45-degree field of view. NIDEK AFC-230.
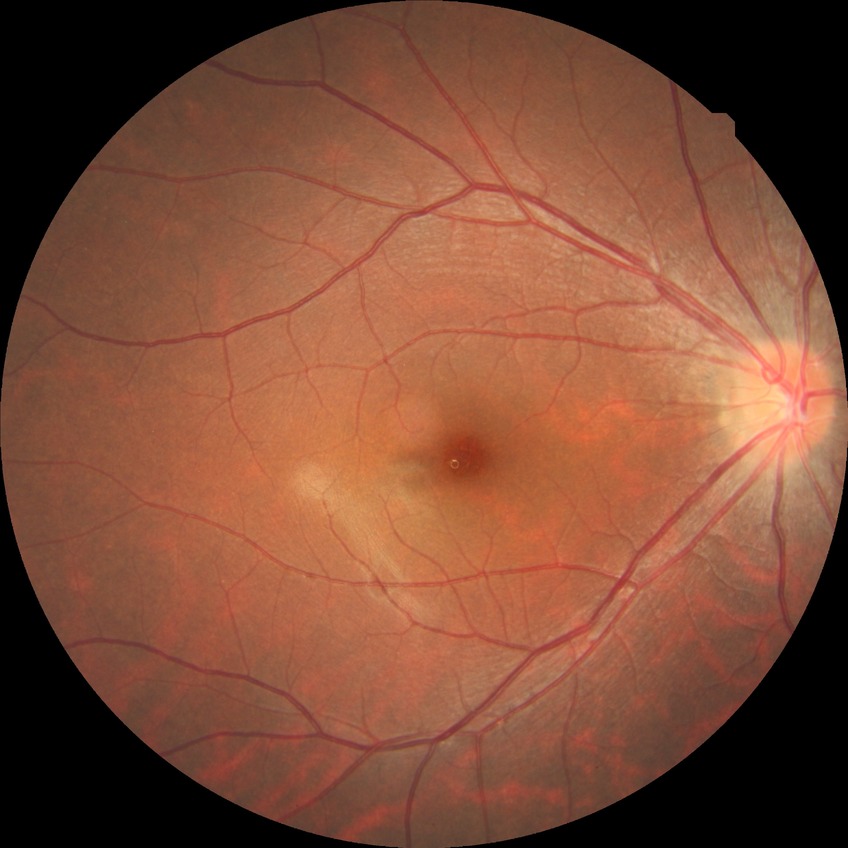

Modified Davis classification: no diabetic retinopathy.